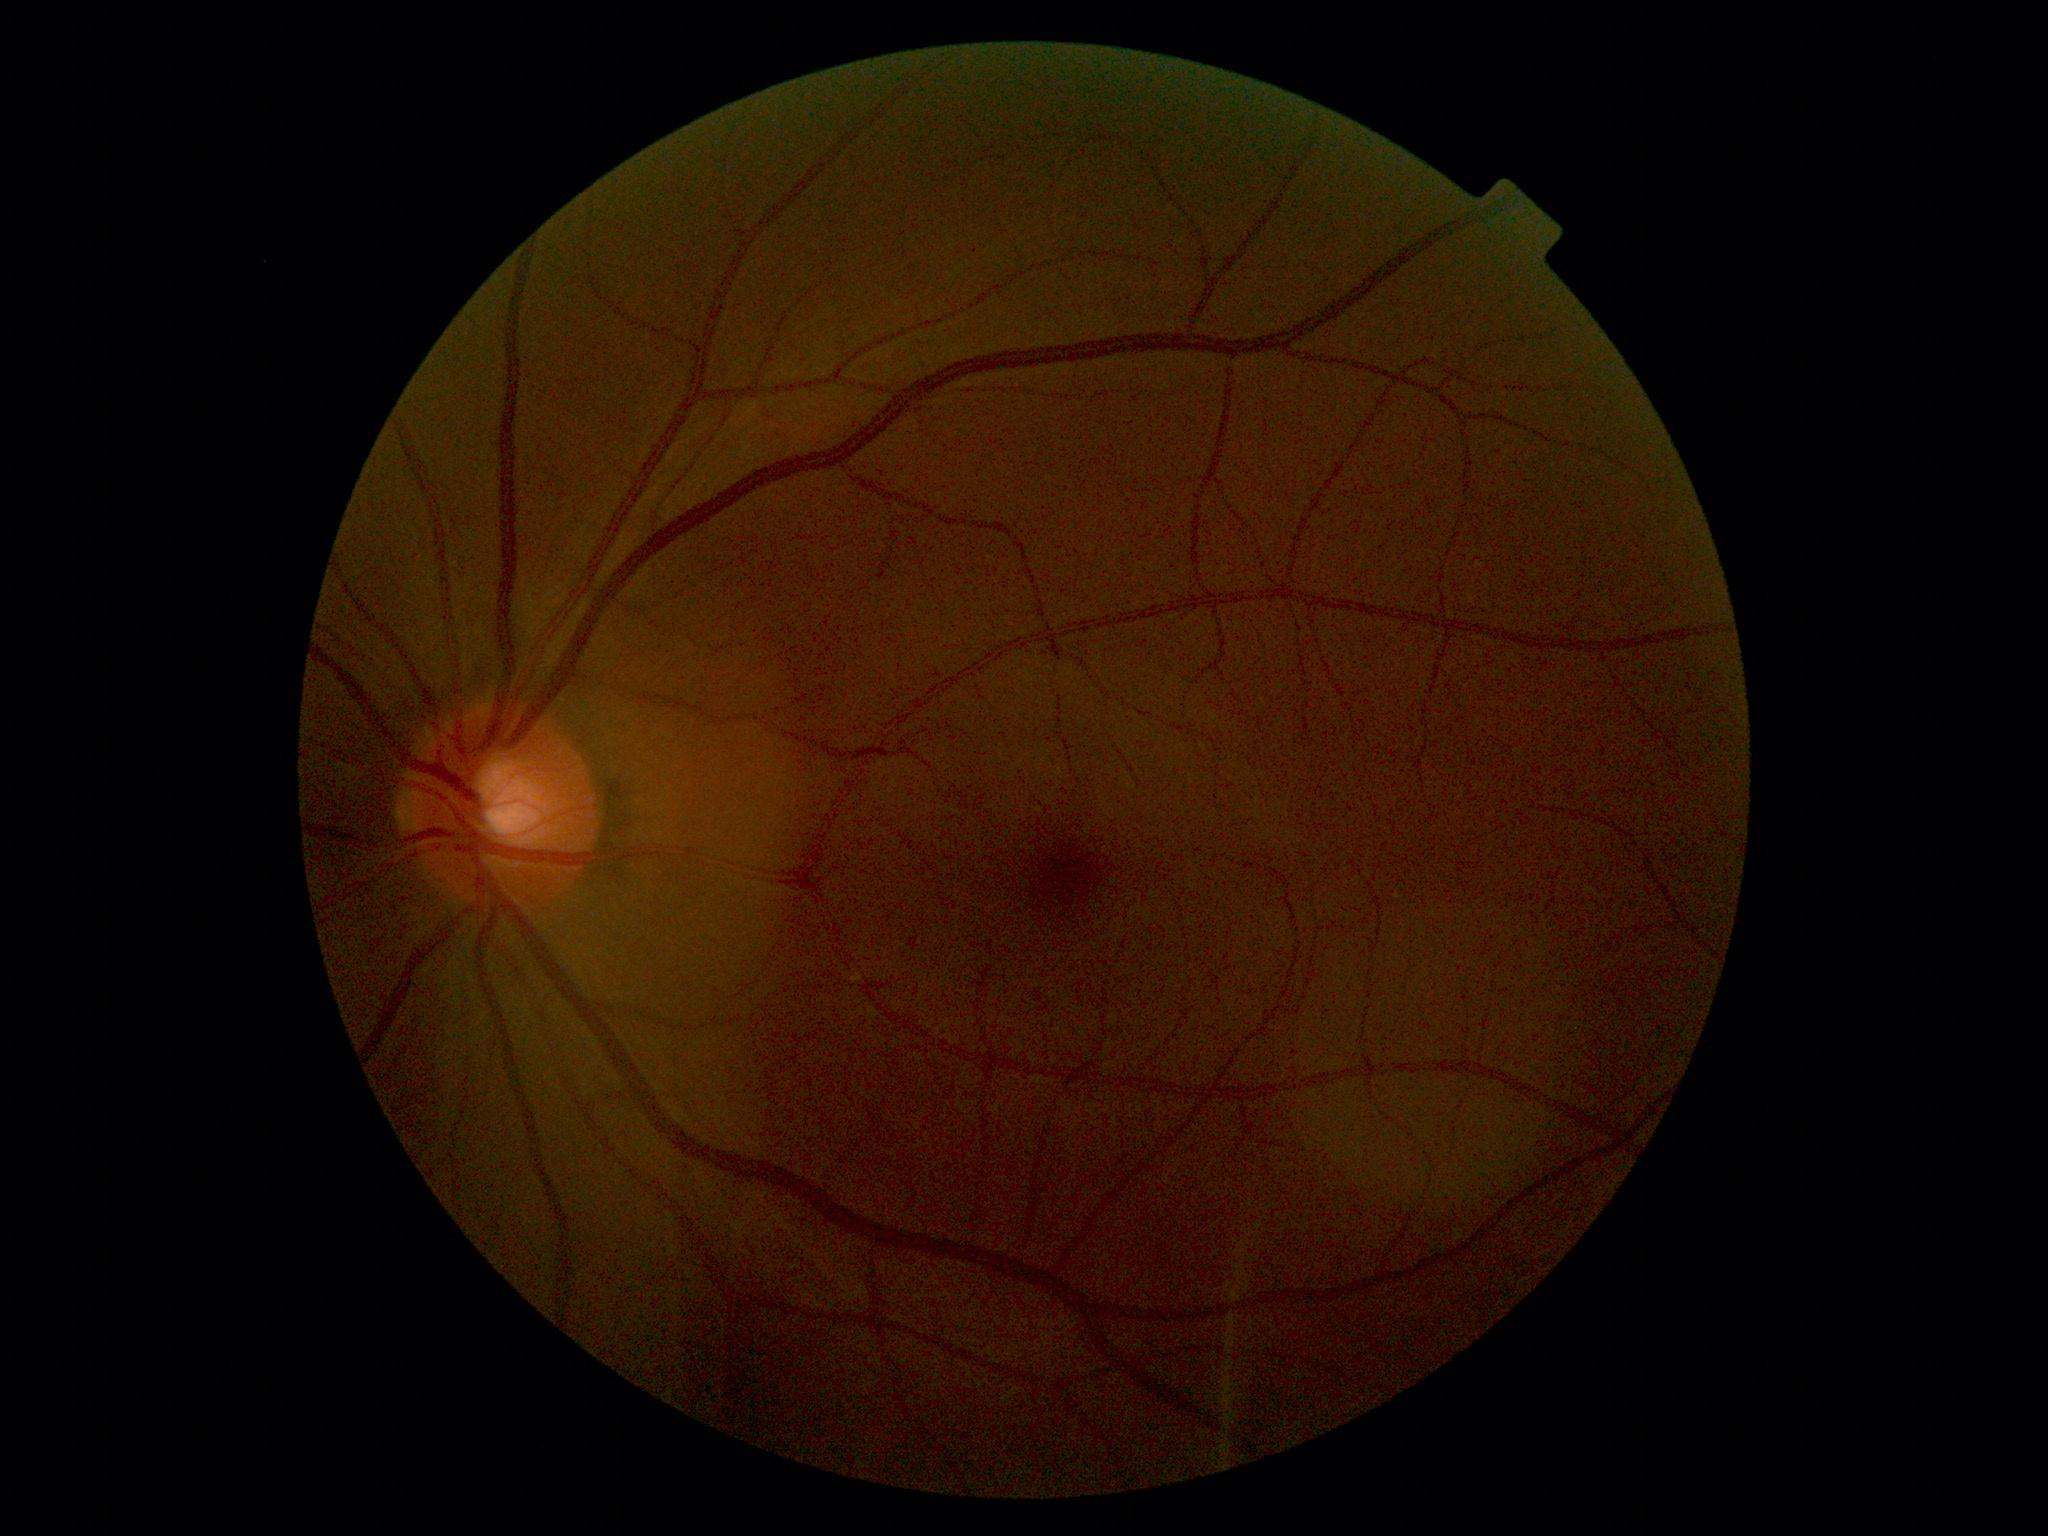

Diabetic retinopathy (DR): 0/4. No diabetic retinal disease findings.